1440 by 1080 pixels. Pediatric retinal photograph (wide-field)
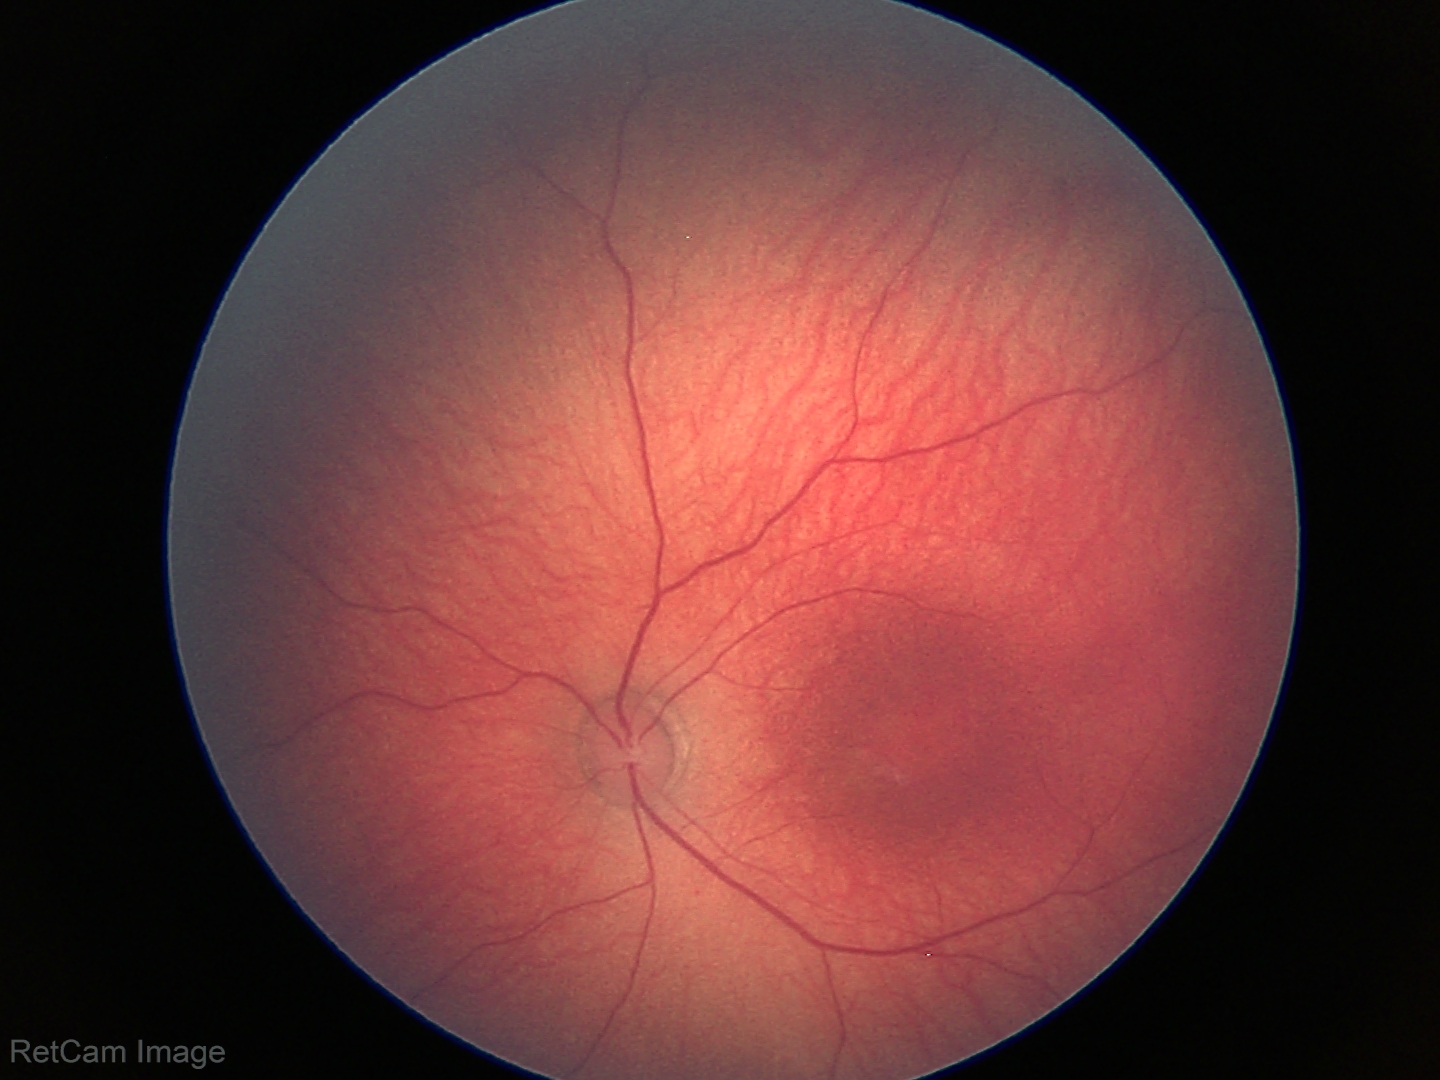 Physiological retinal appearance for postconceptual age.